Diabetic retinopathy graded by the modified Davis classification · NIDEK AFC-230:
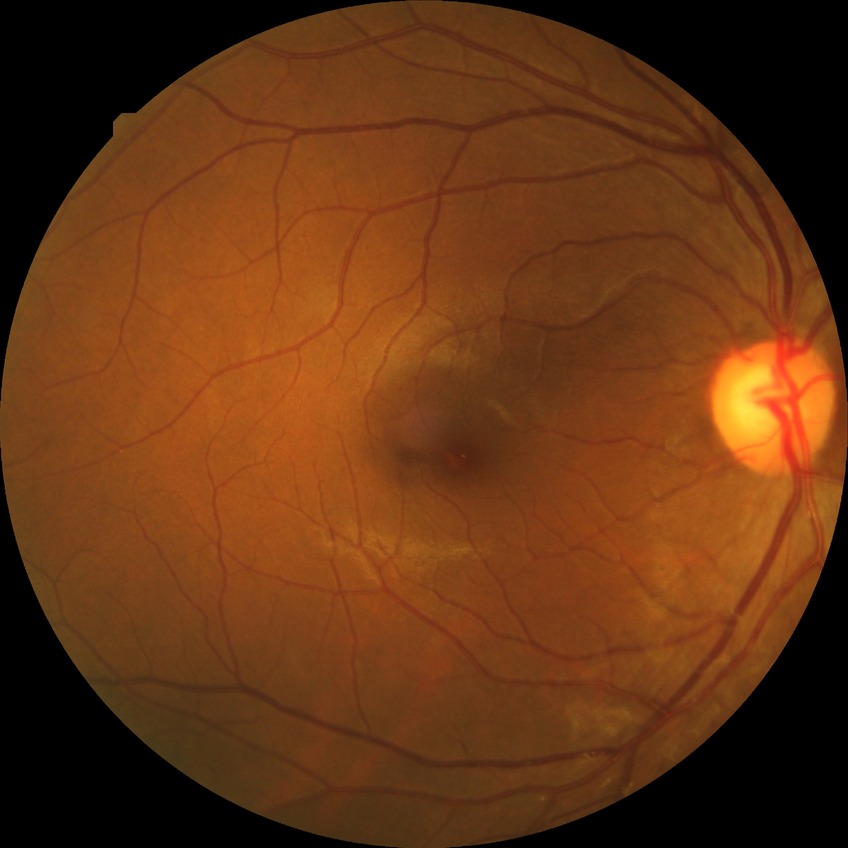   davis_grade: no diabetic retinopathy